Modified Davis grading.
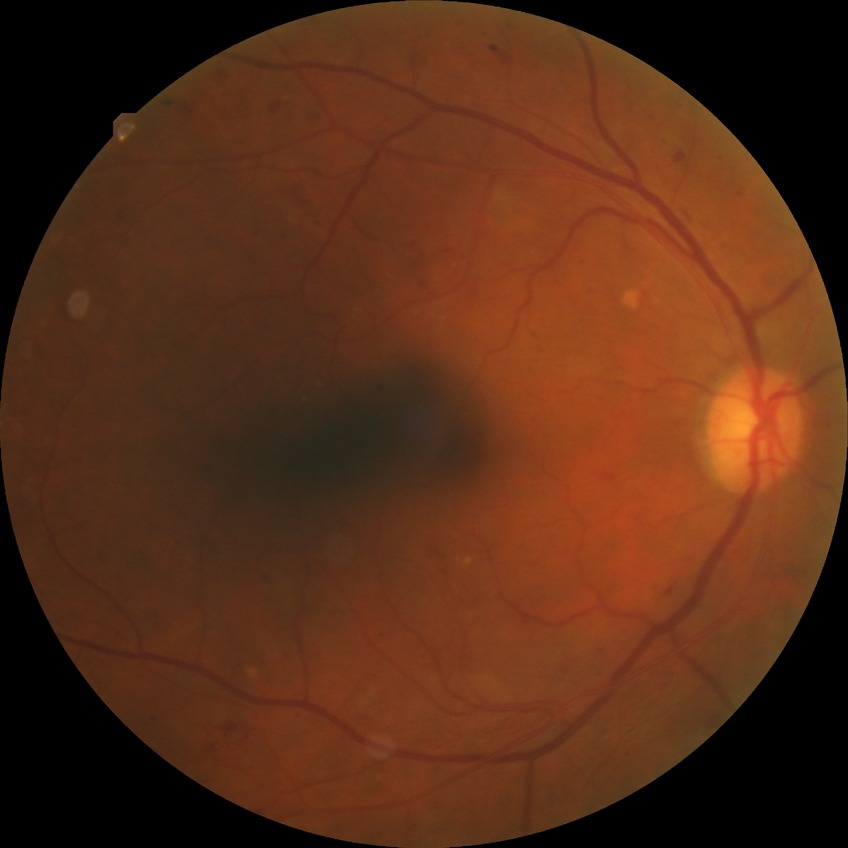 Diabetic retinopathy stage is proliferative diabetic retinopathy.